45° FOV; image size 2352x1568; fundus photo.
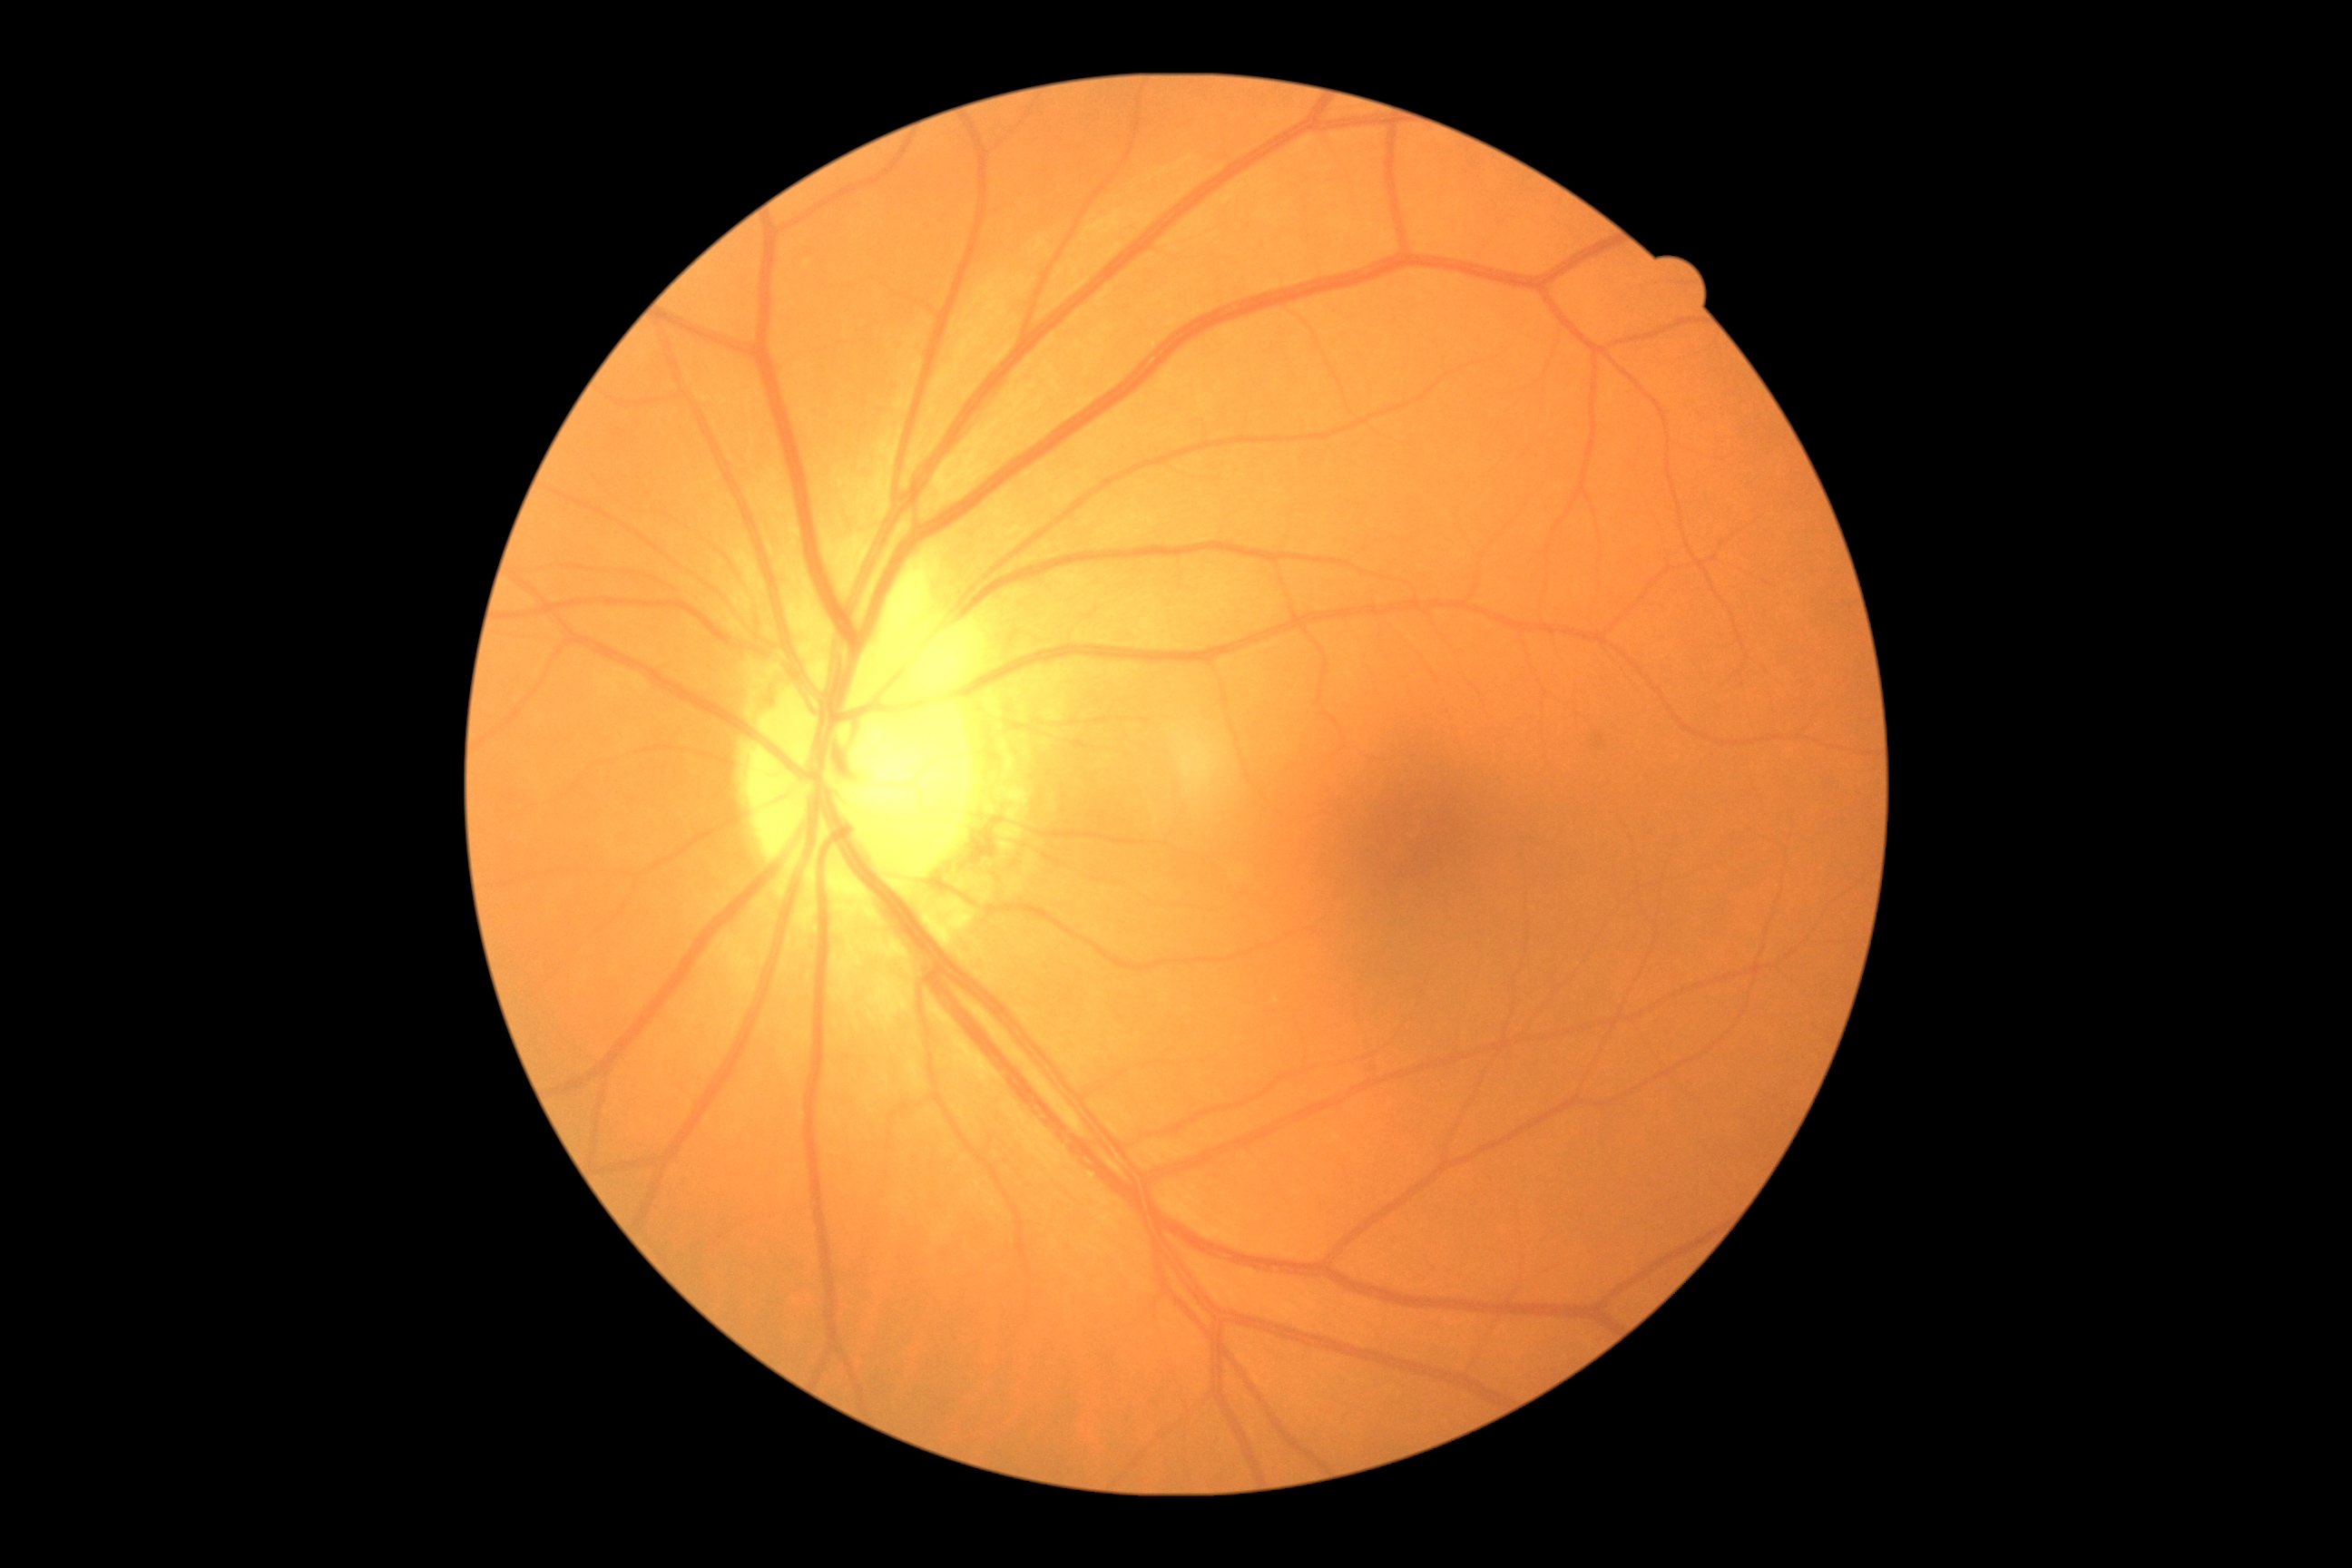 {"dr_grade": "grade 0"}